FOV: 45 degrees:
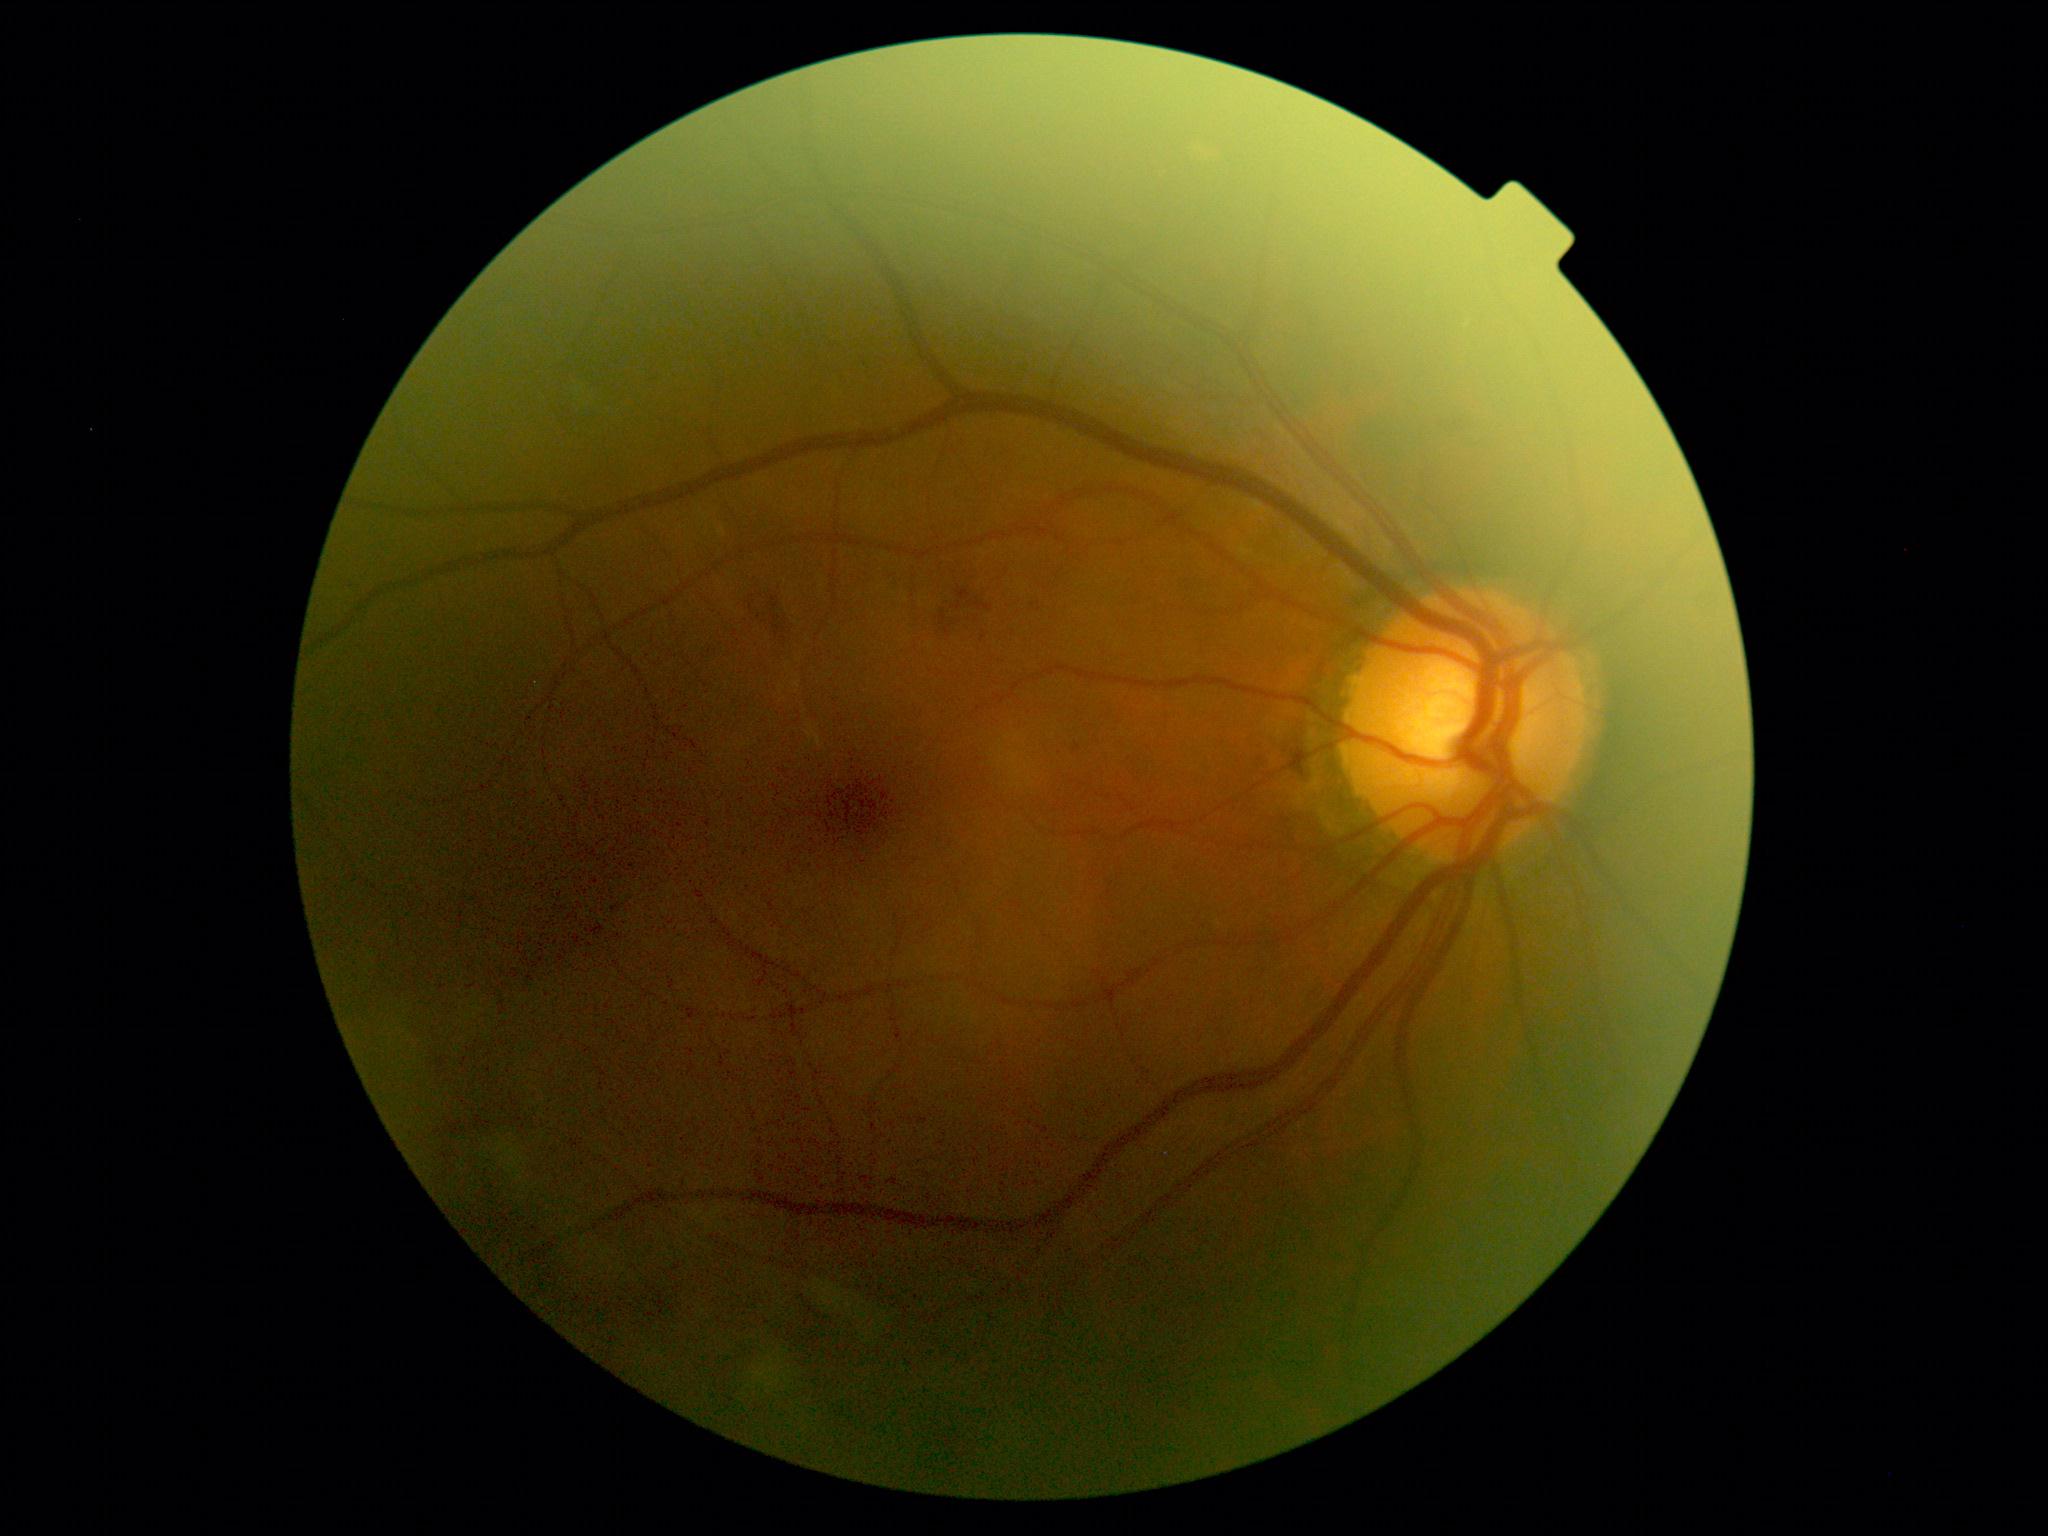 DR class: non-proliferative diabetic retinopathy, retinopathy: grade 2 (moderate NPDR) — more than just microaneurysms but less than severe NPDR.